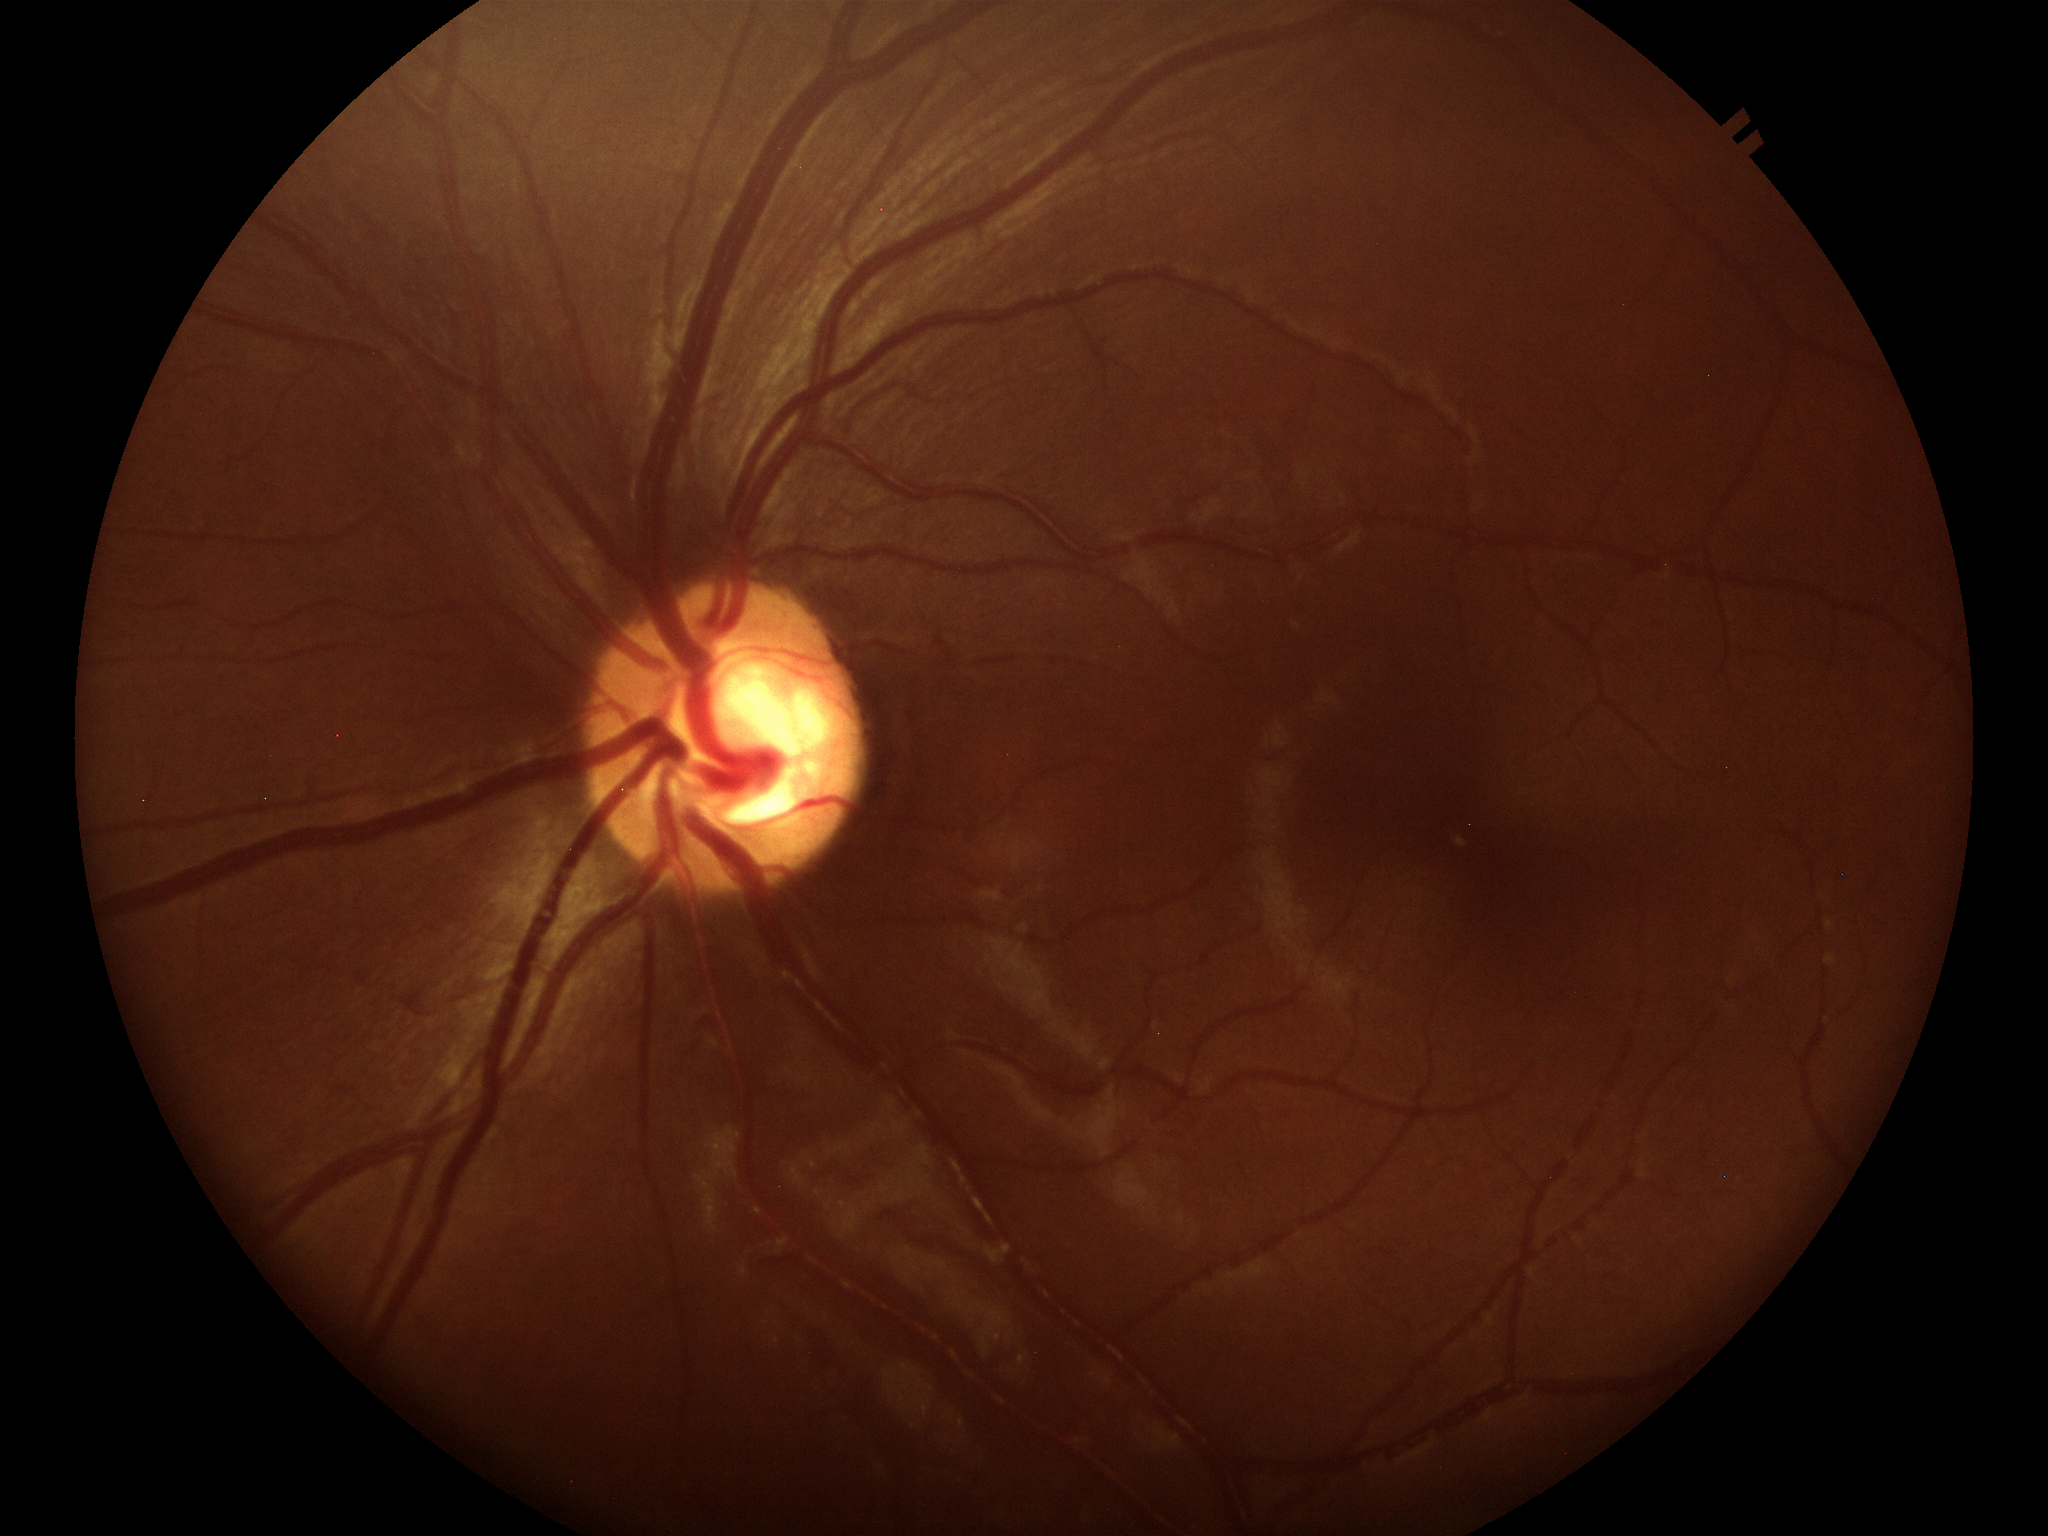 VCDR=0.59
Glaucoma screening impression=suspicious findings
HCDR=0.60